Ultra-widefield (UWF) fundus image
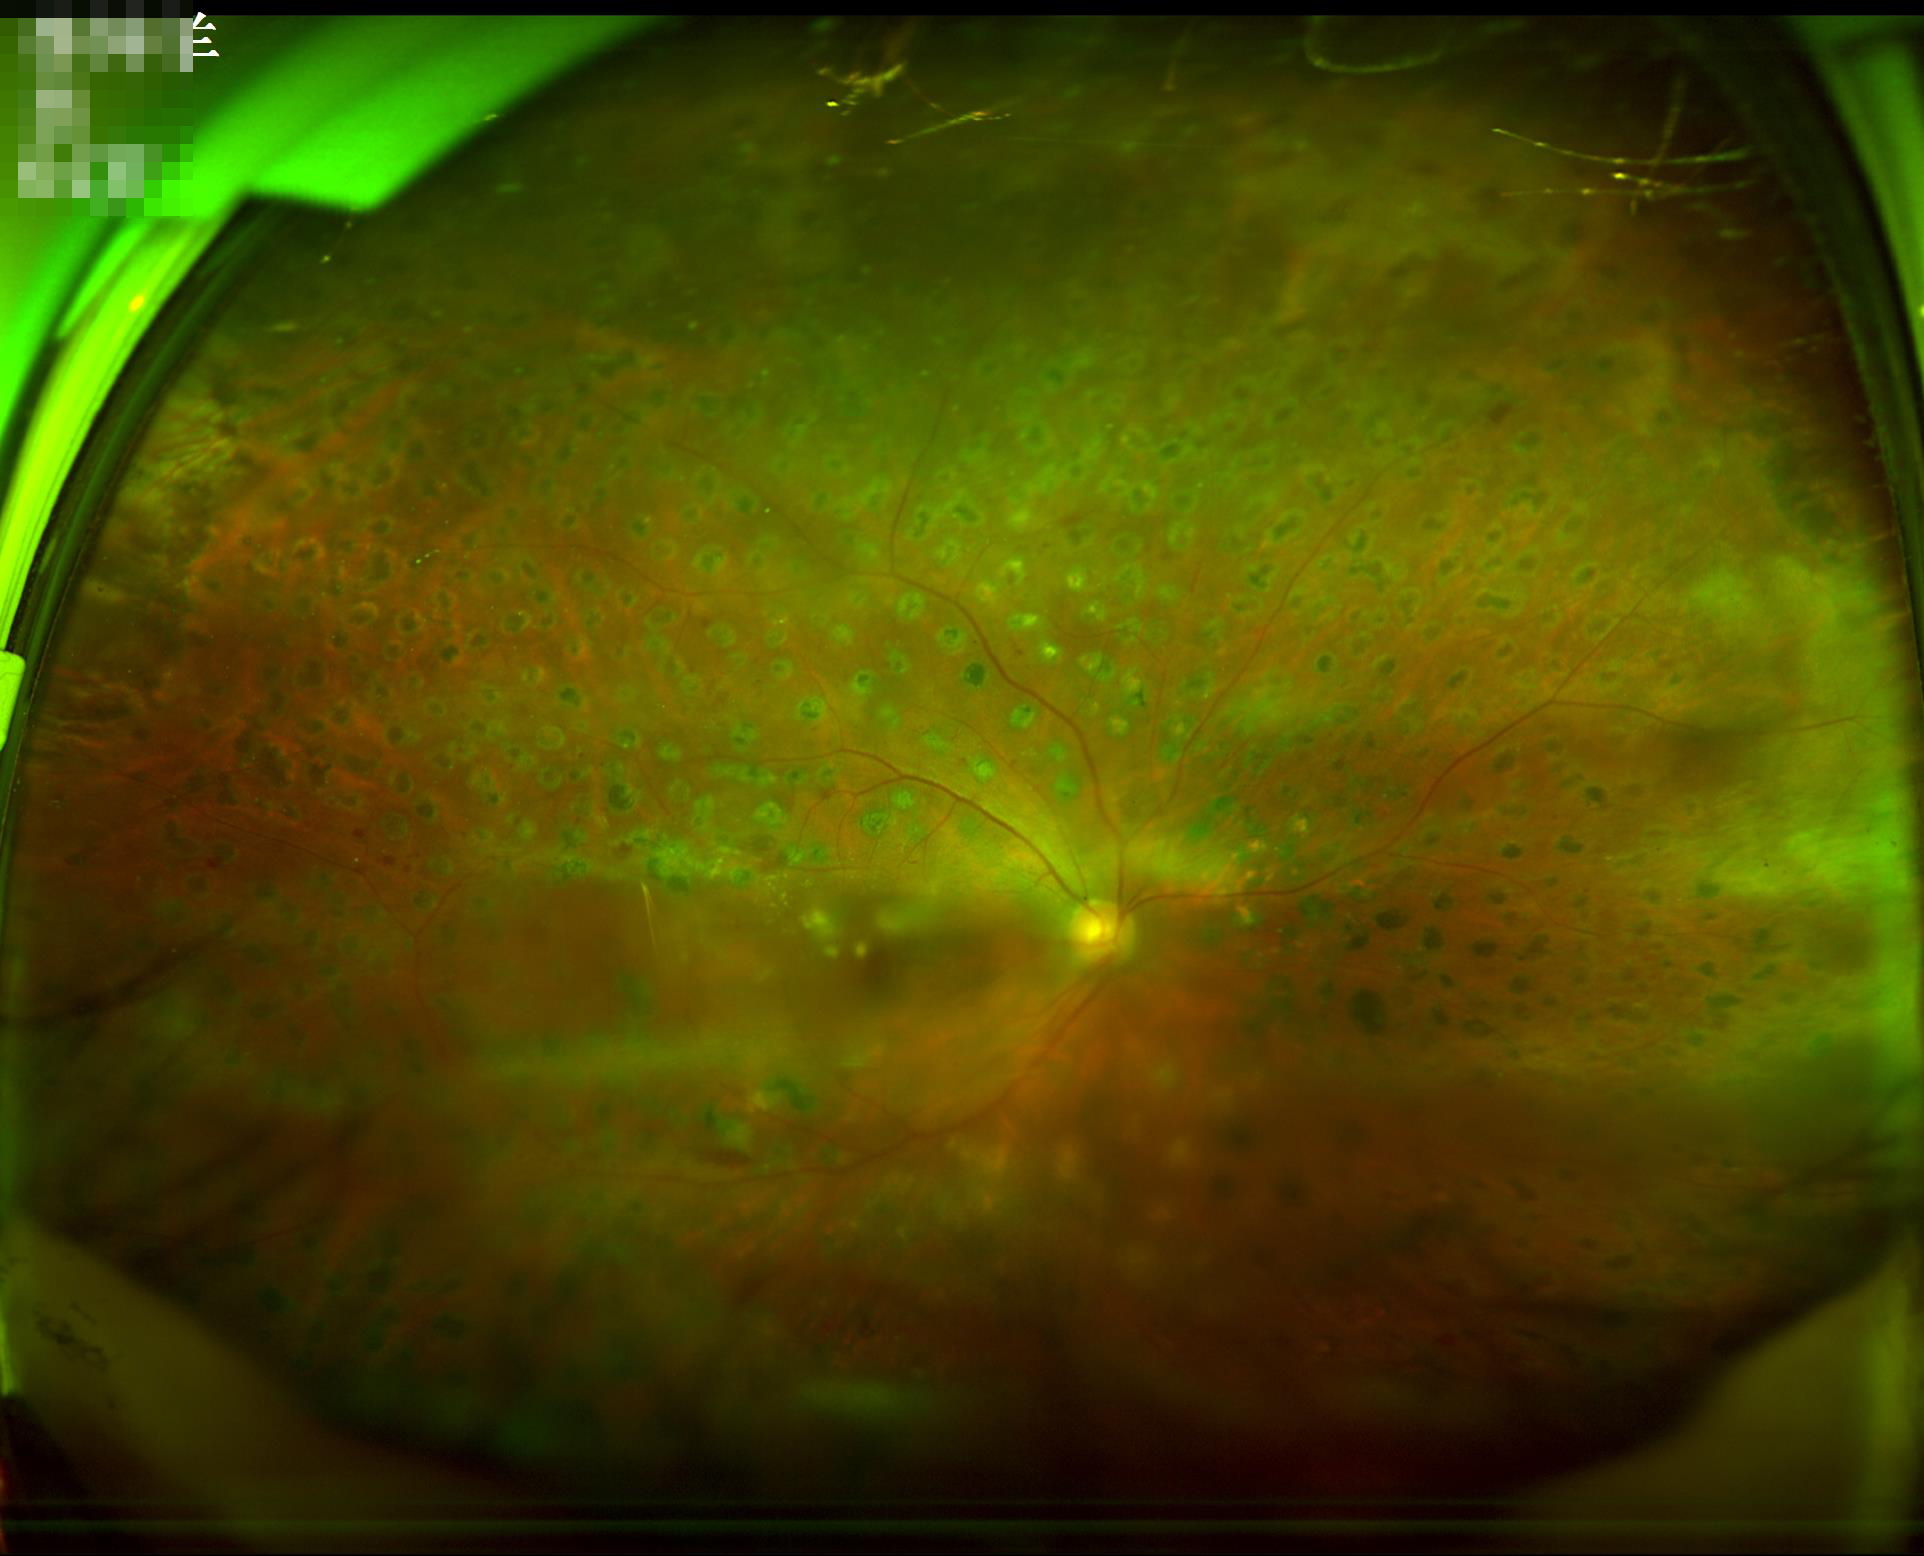
Illumination is even.
Overall image quality is poor.
Out of focus; structures are indistinct.